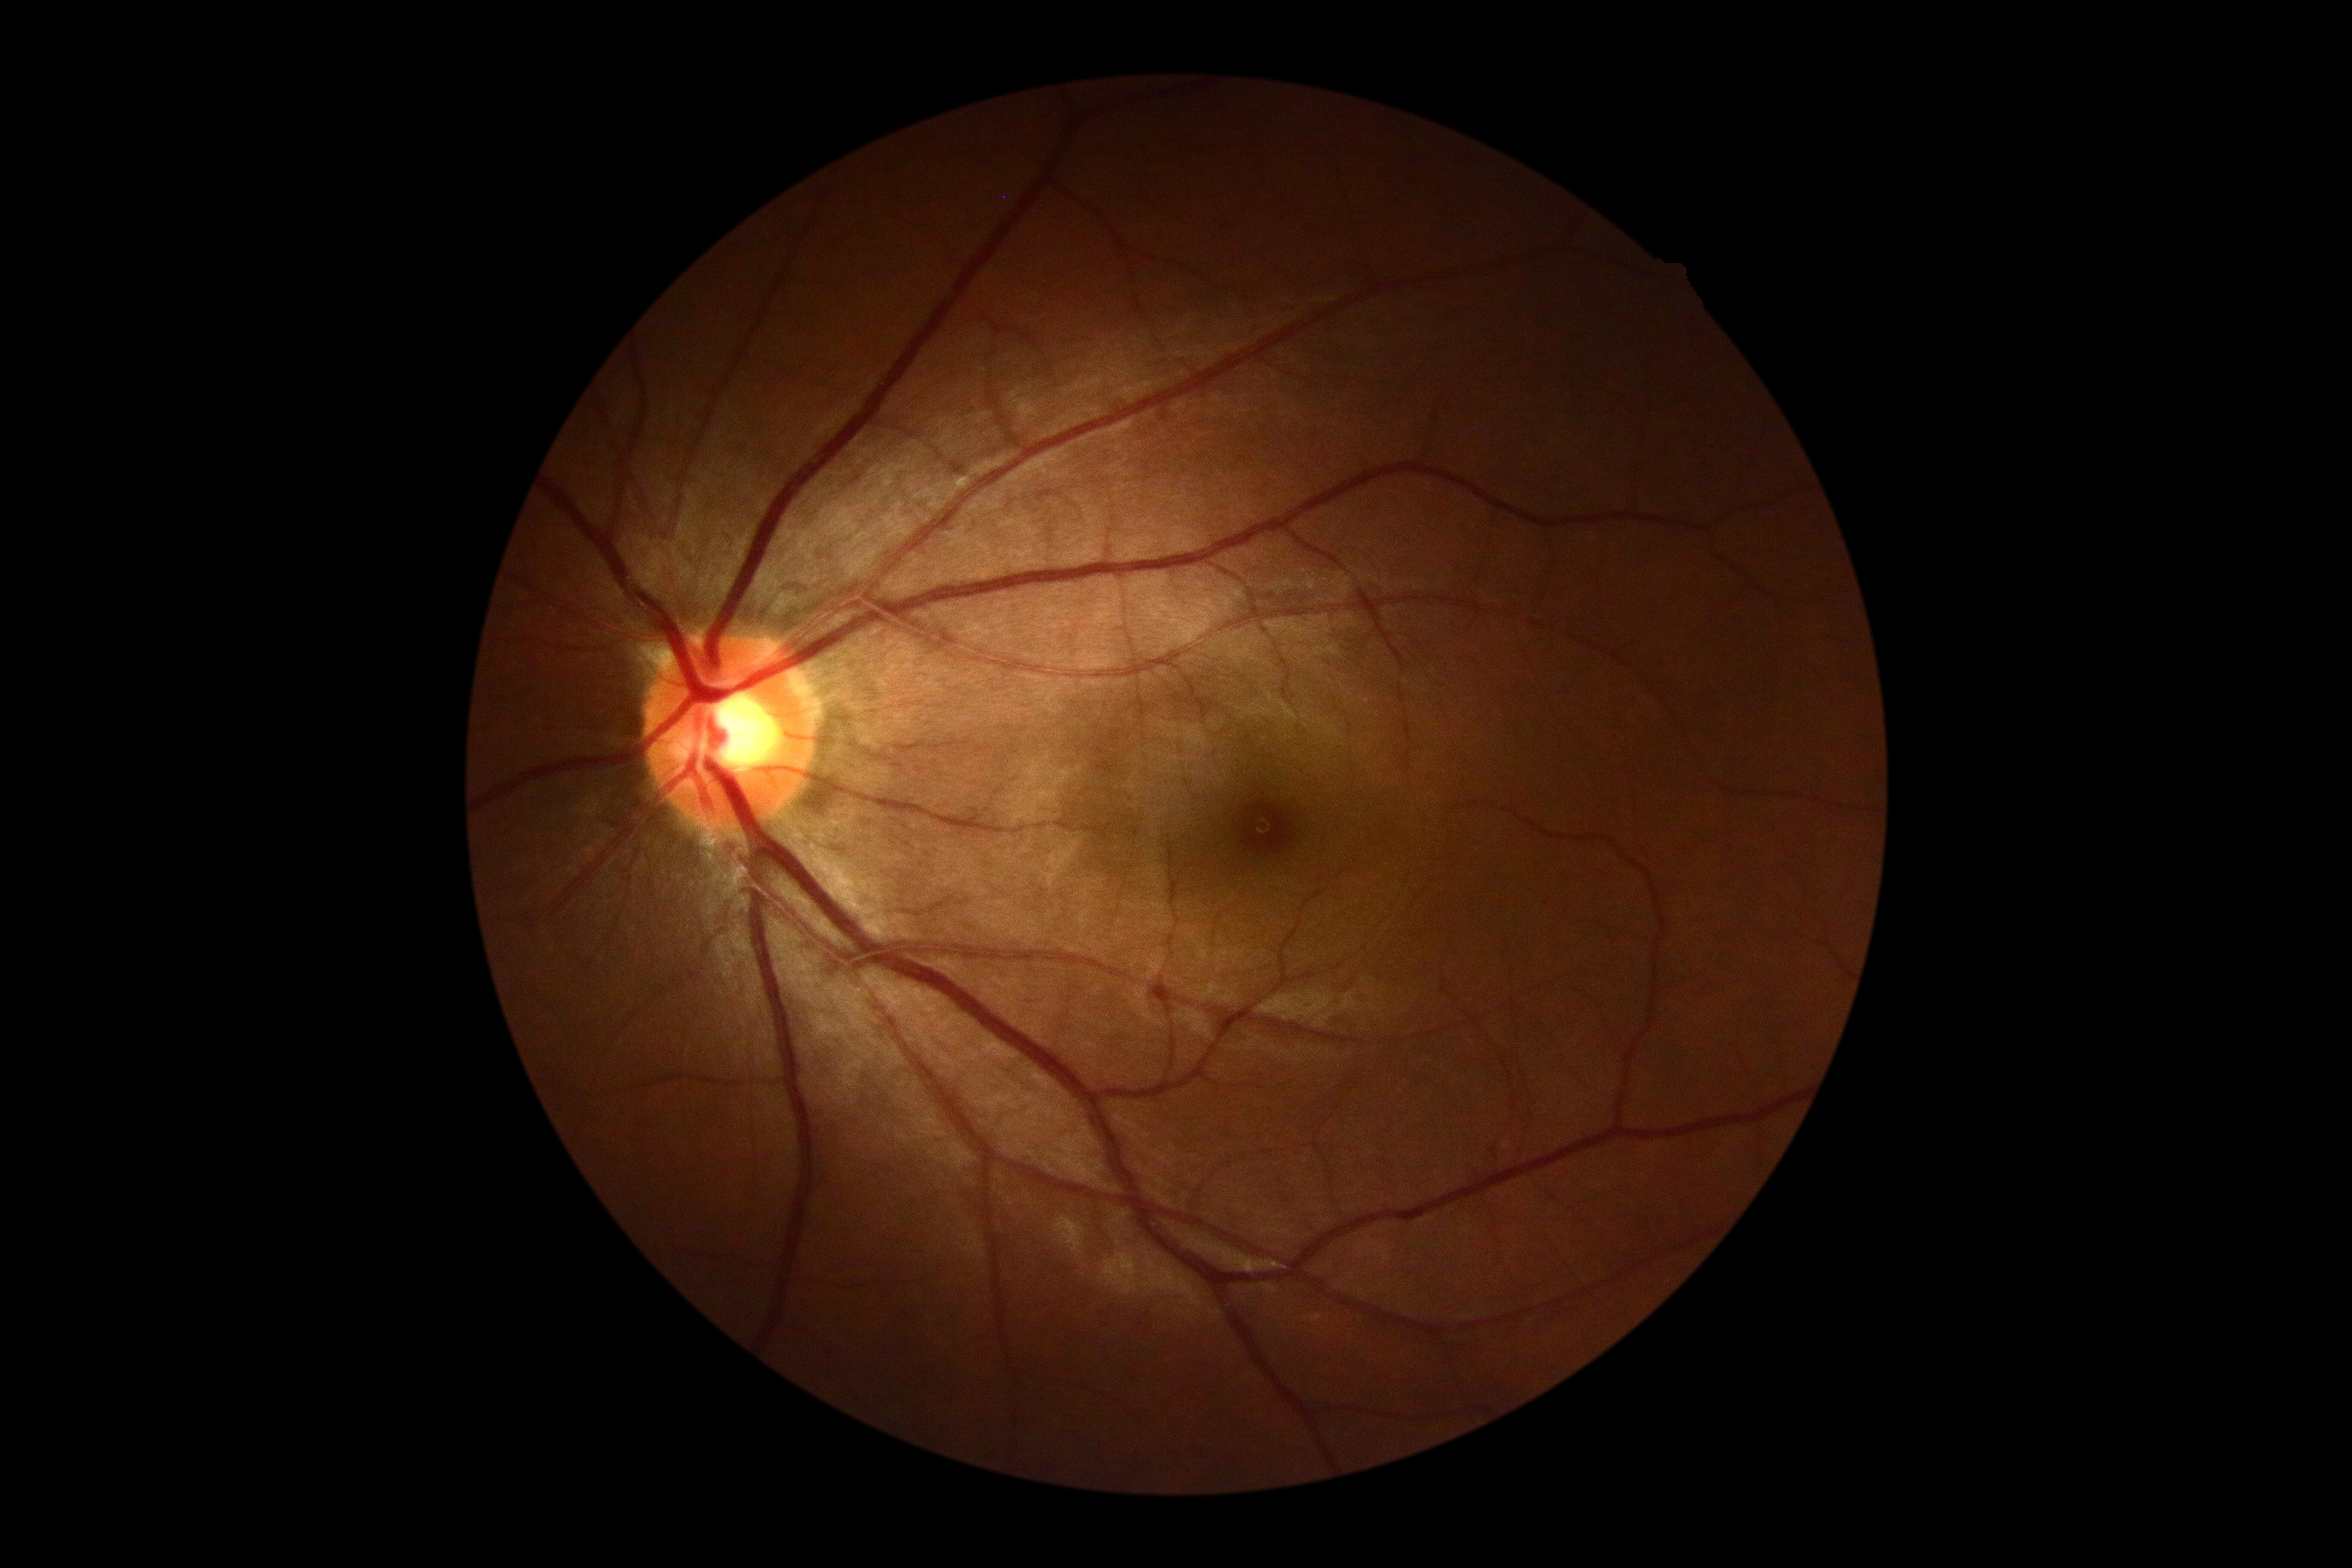 {
  "dr_grade": "0"
}